Color fundus photograph · FOV: 45 degrees: 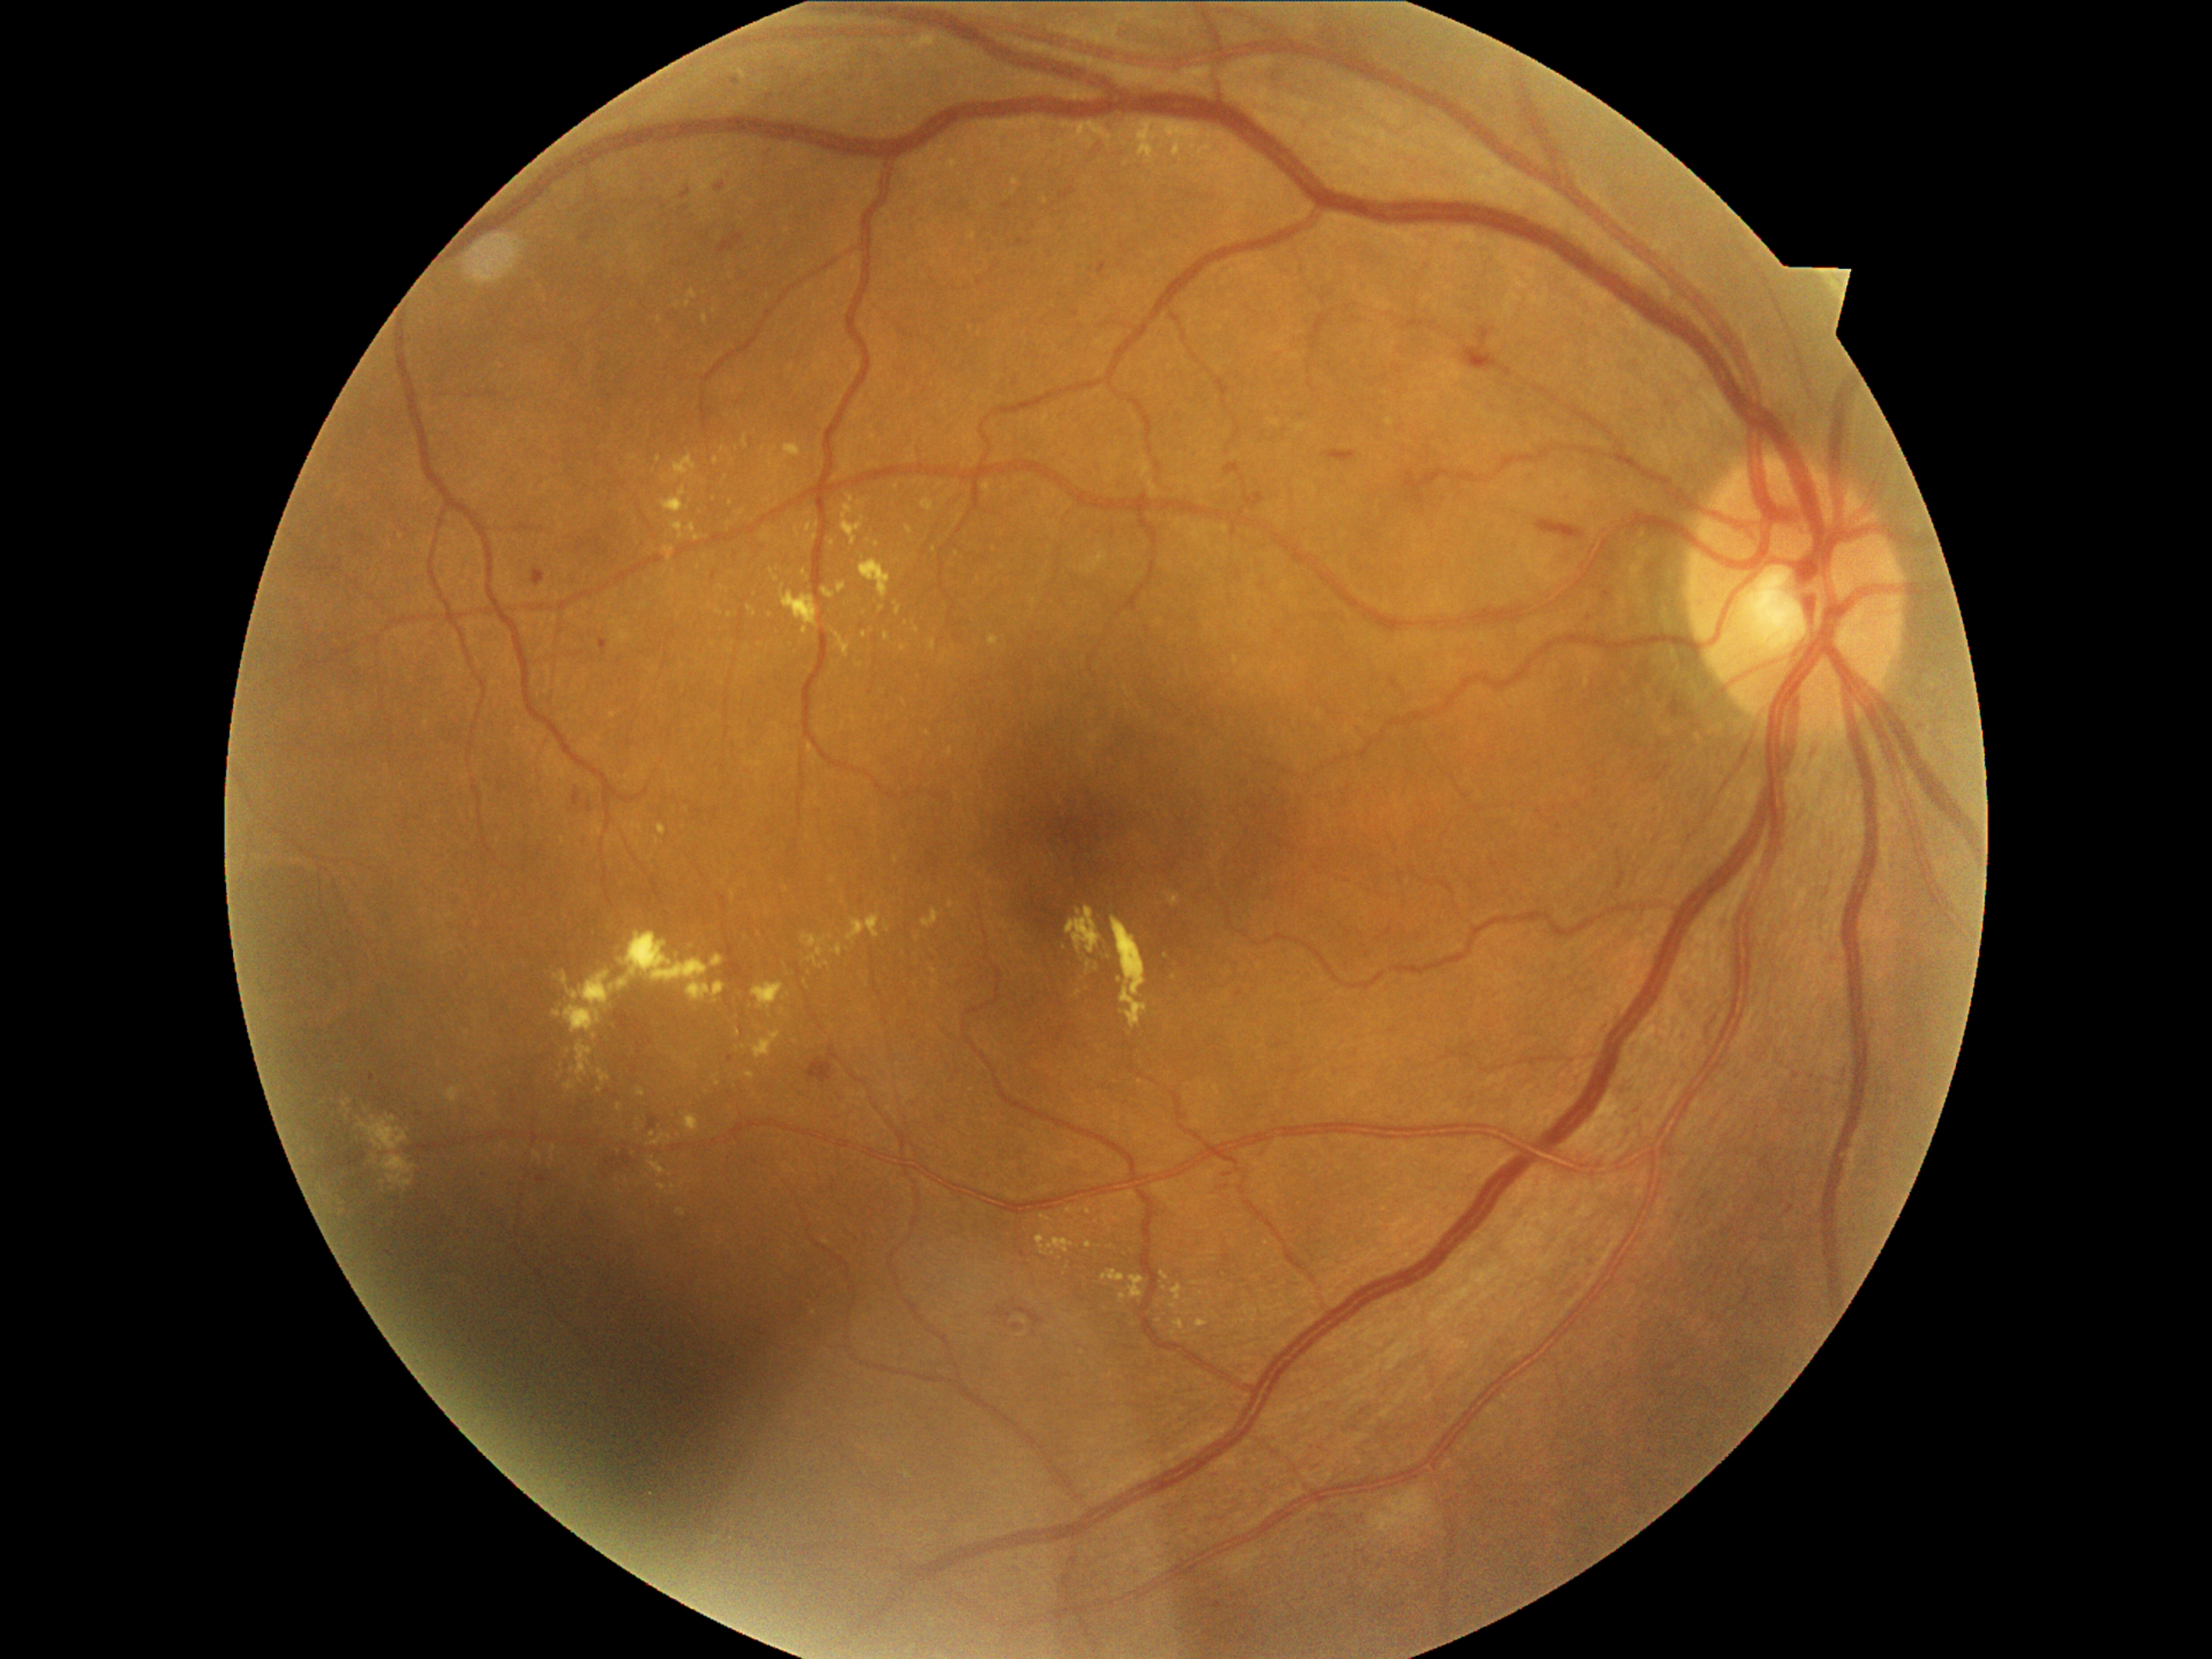
{"partial":true,"dr_grade":2,"dr_grade_name":"moderate NPDR","lesions":{"ex":[[598,1069,610,1086],[1020,1317,1028,1325],[923,909,940,929],[859,559,892,602],[564,1081,574,1091],[752,1030,781,1059],[702,315,707,323],[742,436,748,450],[1196,1318,1209,1329],[535,1153,544,1160],[1121,1295,1127,1303]],"ex_small_centers":[[1095,969],[932,971],[698,538],[674,1187],[898,560],[692,501],[934,549]]}}